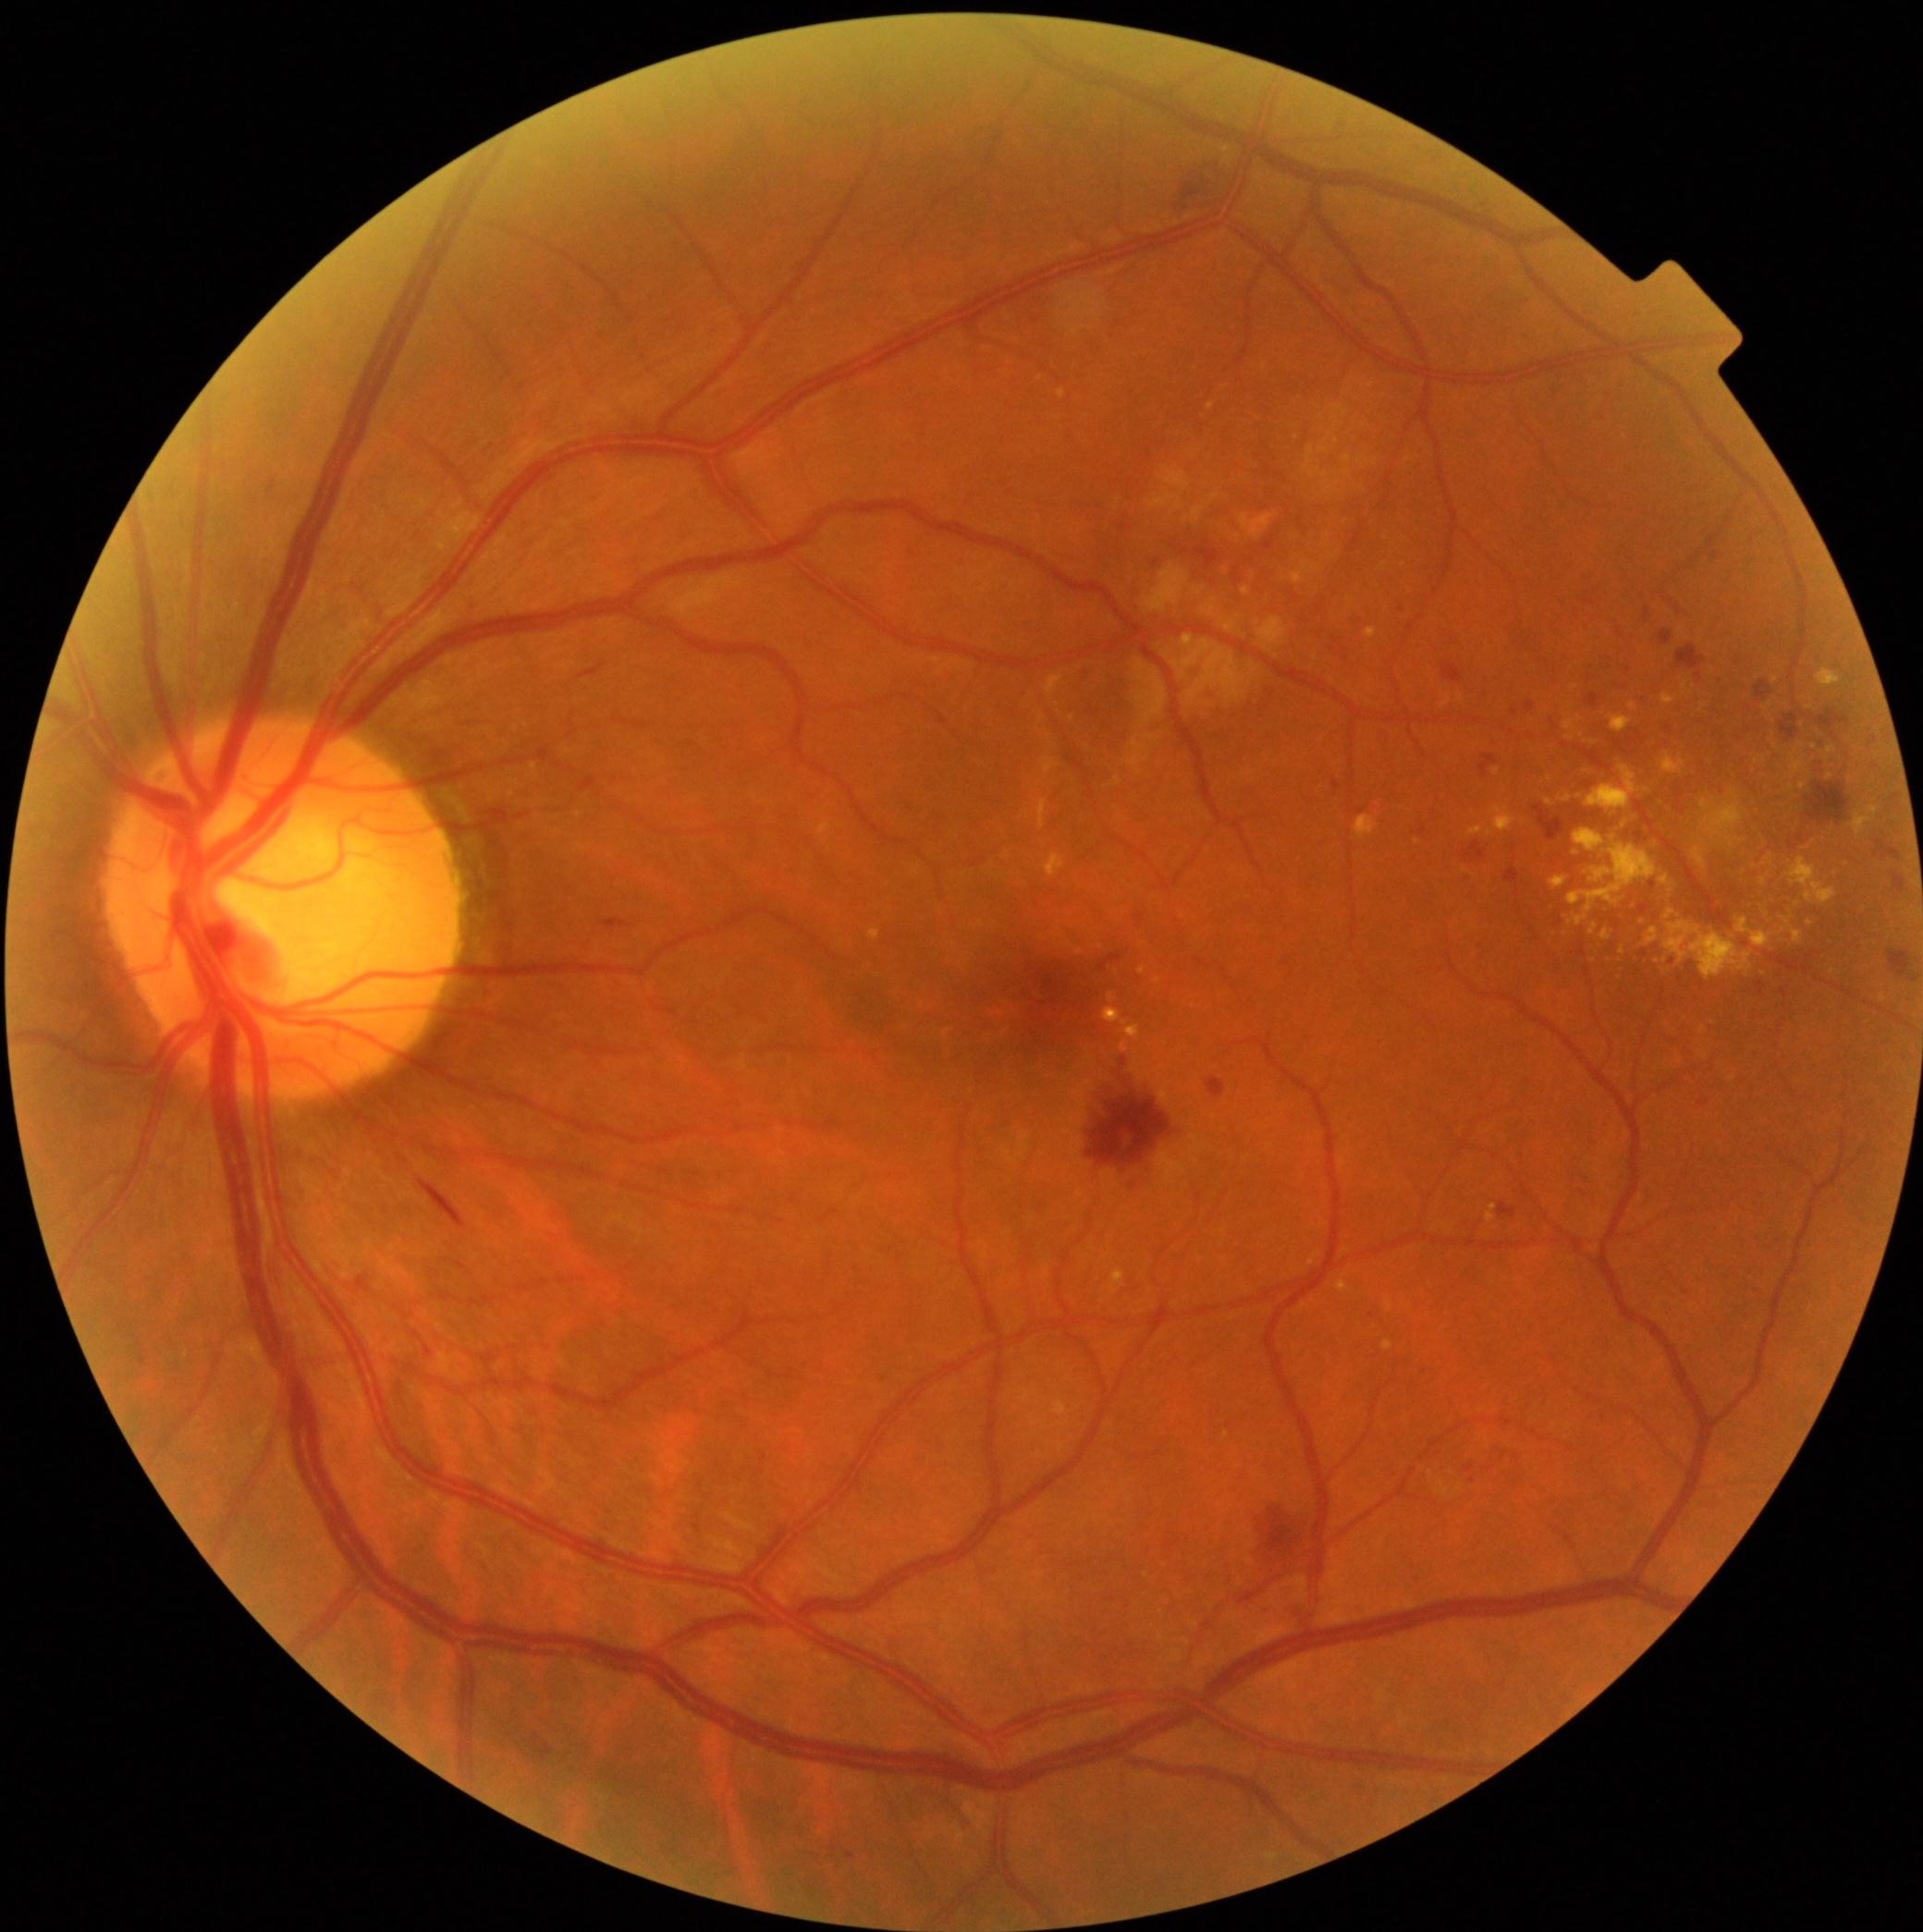 DR stage is moderate non-proliferative diabetic retinopathy (grade 2); non-proliferative diabetic retinopathy.
EXs include those at box=[1366, 629, 1377, 640]; box=[1701, 799, 1716, 813]; box=[1058, 390, 1065, 400]; box=[1586, 765, 1639, 818]; box=[1694, 848, 1707, 870]; box=[1793, 930, 1804, 946]; box=[1564, 797, 1572, 803]; box=[1660, 876, 1669, 886]; box=[1736, 919, 1772, 949]; box=[1817, 669, 1843, 689]; box=[1630, 703, 1637, 711]; box=[1304, 563, 1317, 574]; box=[1853, 814, 1873, 837].
EXs (small, approximate centers) near [x=1490, y=835]; [x=1594, y=962]; [x=1775, y=681]; [x=1417, y=843]; [x=1497, y=772]; [x=1830, y=776].